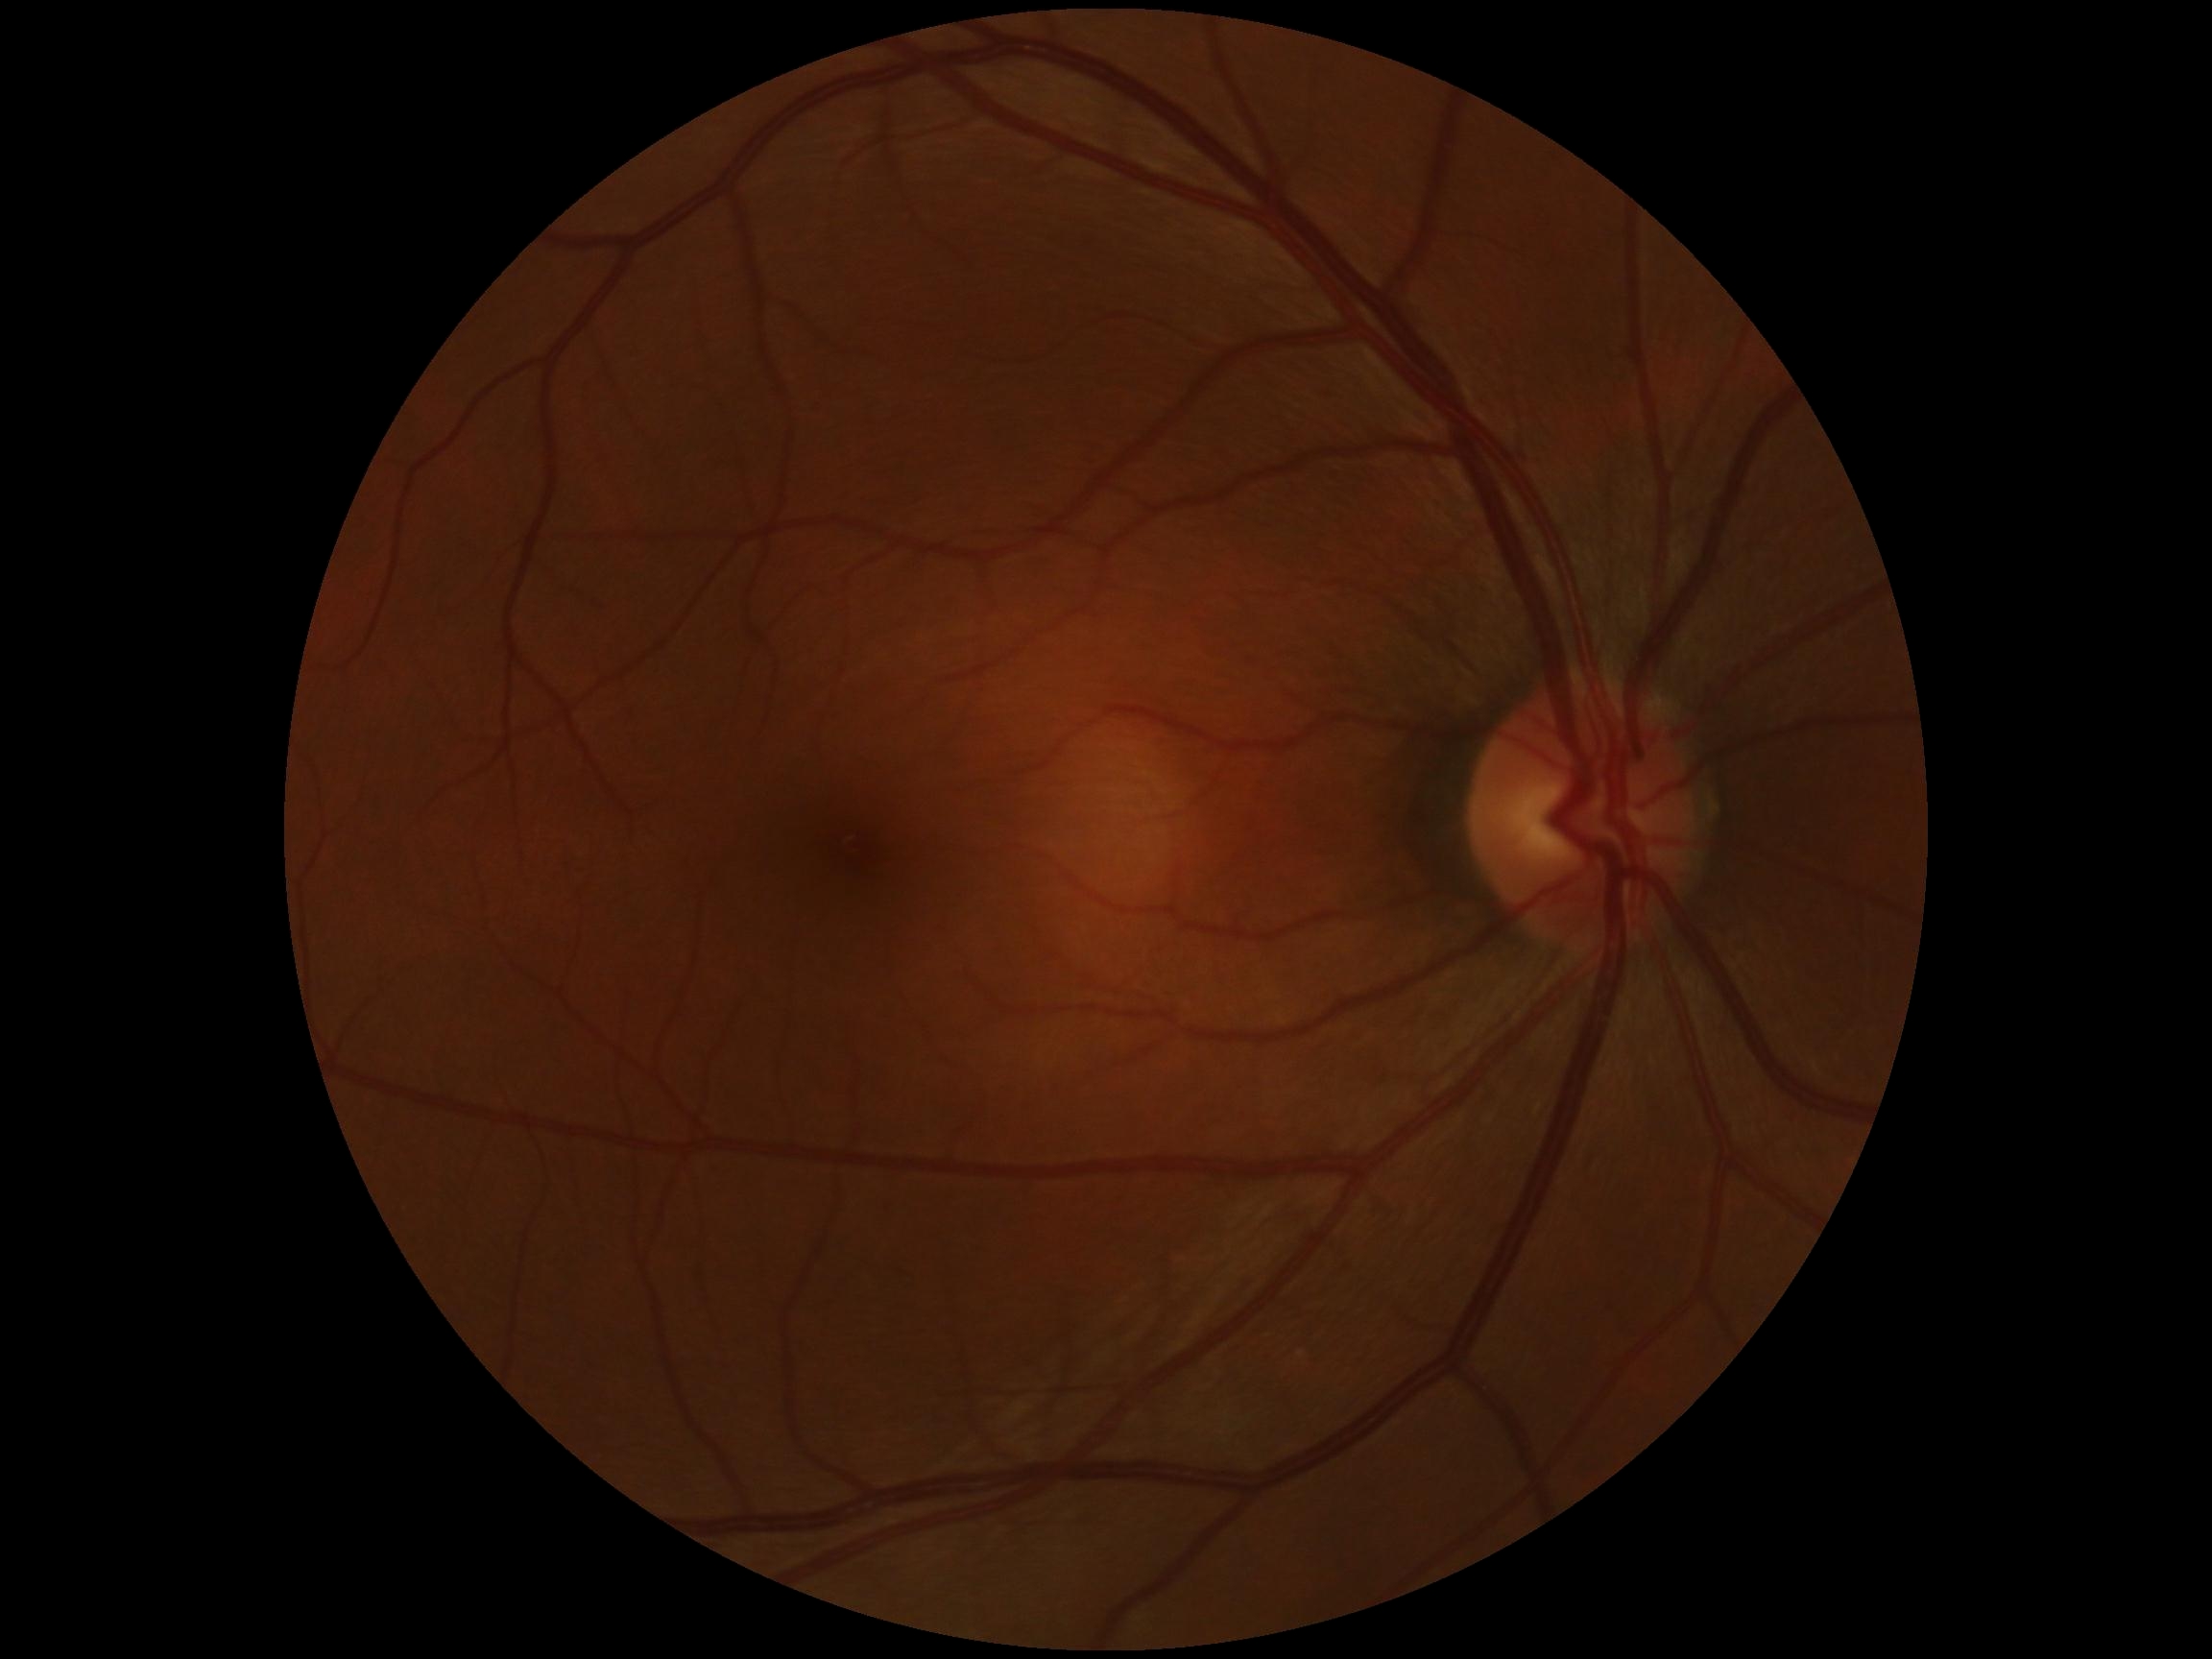
dr_impression: negative for DR
dr_grade: grade 0